45-degree field of view. 2212 by 1659 pixels. Retinal fundus photograph — 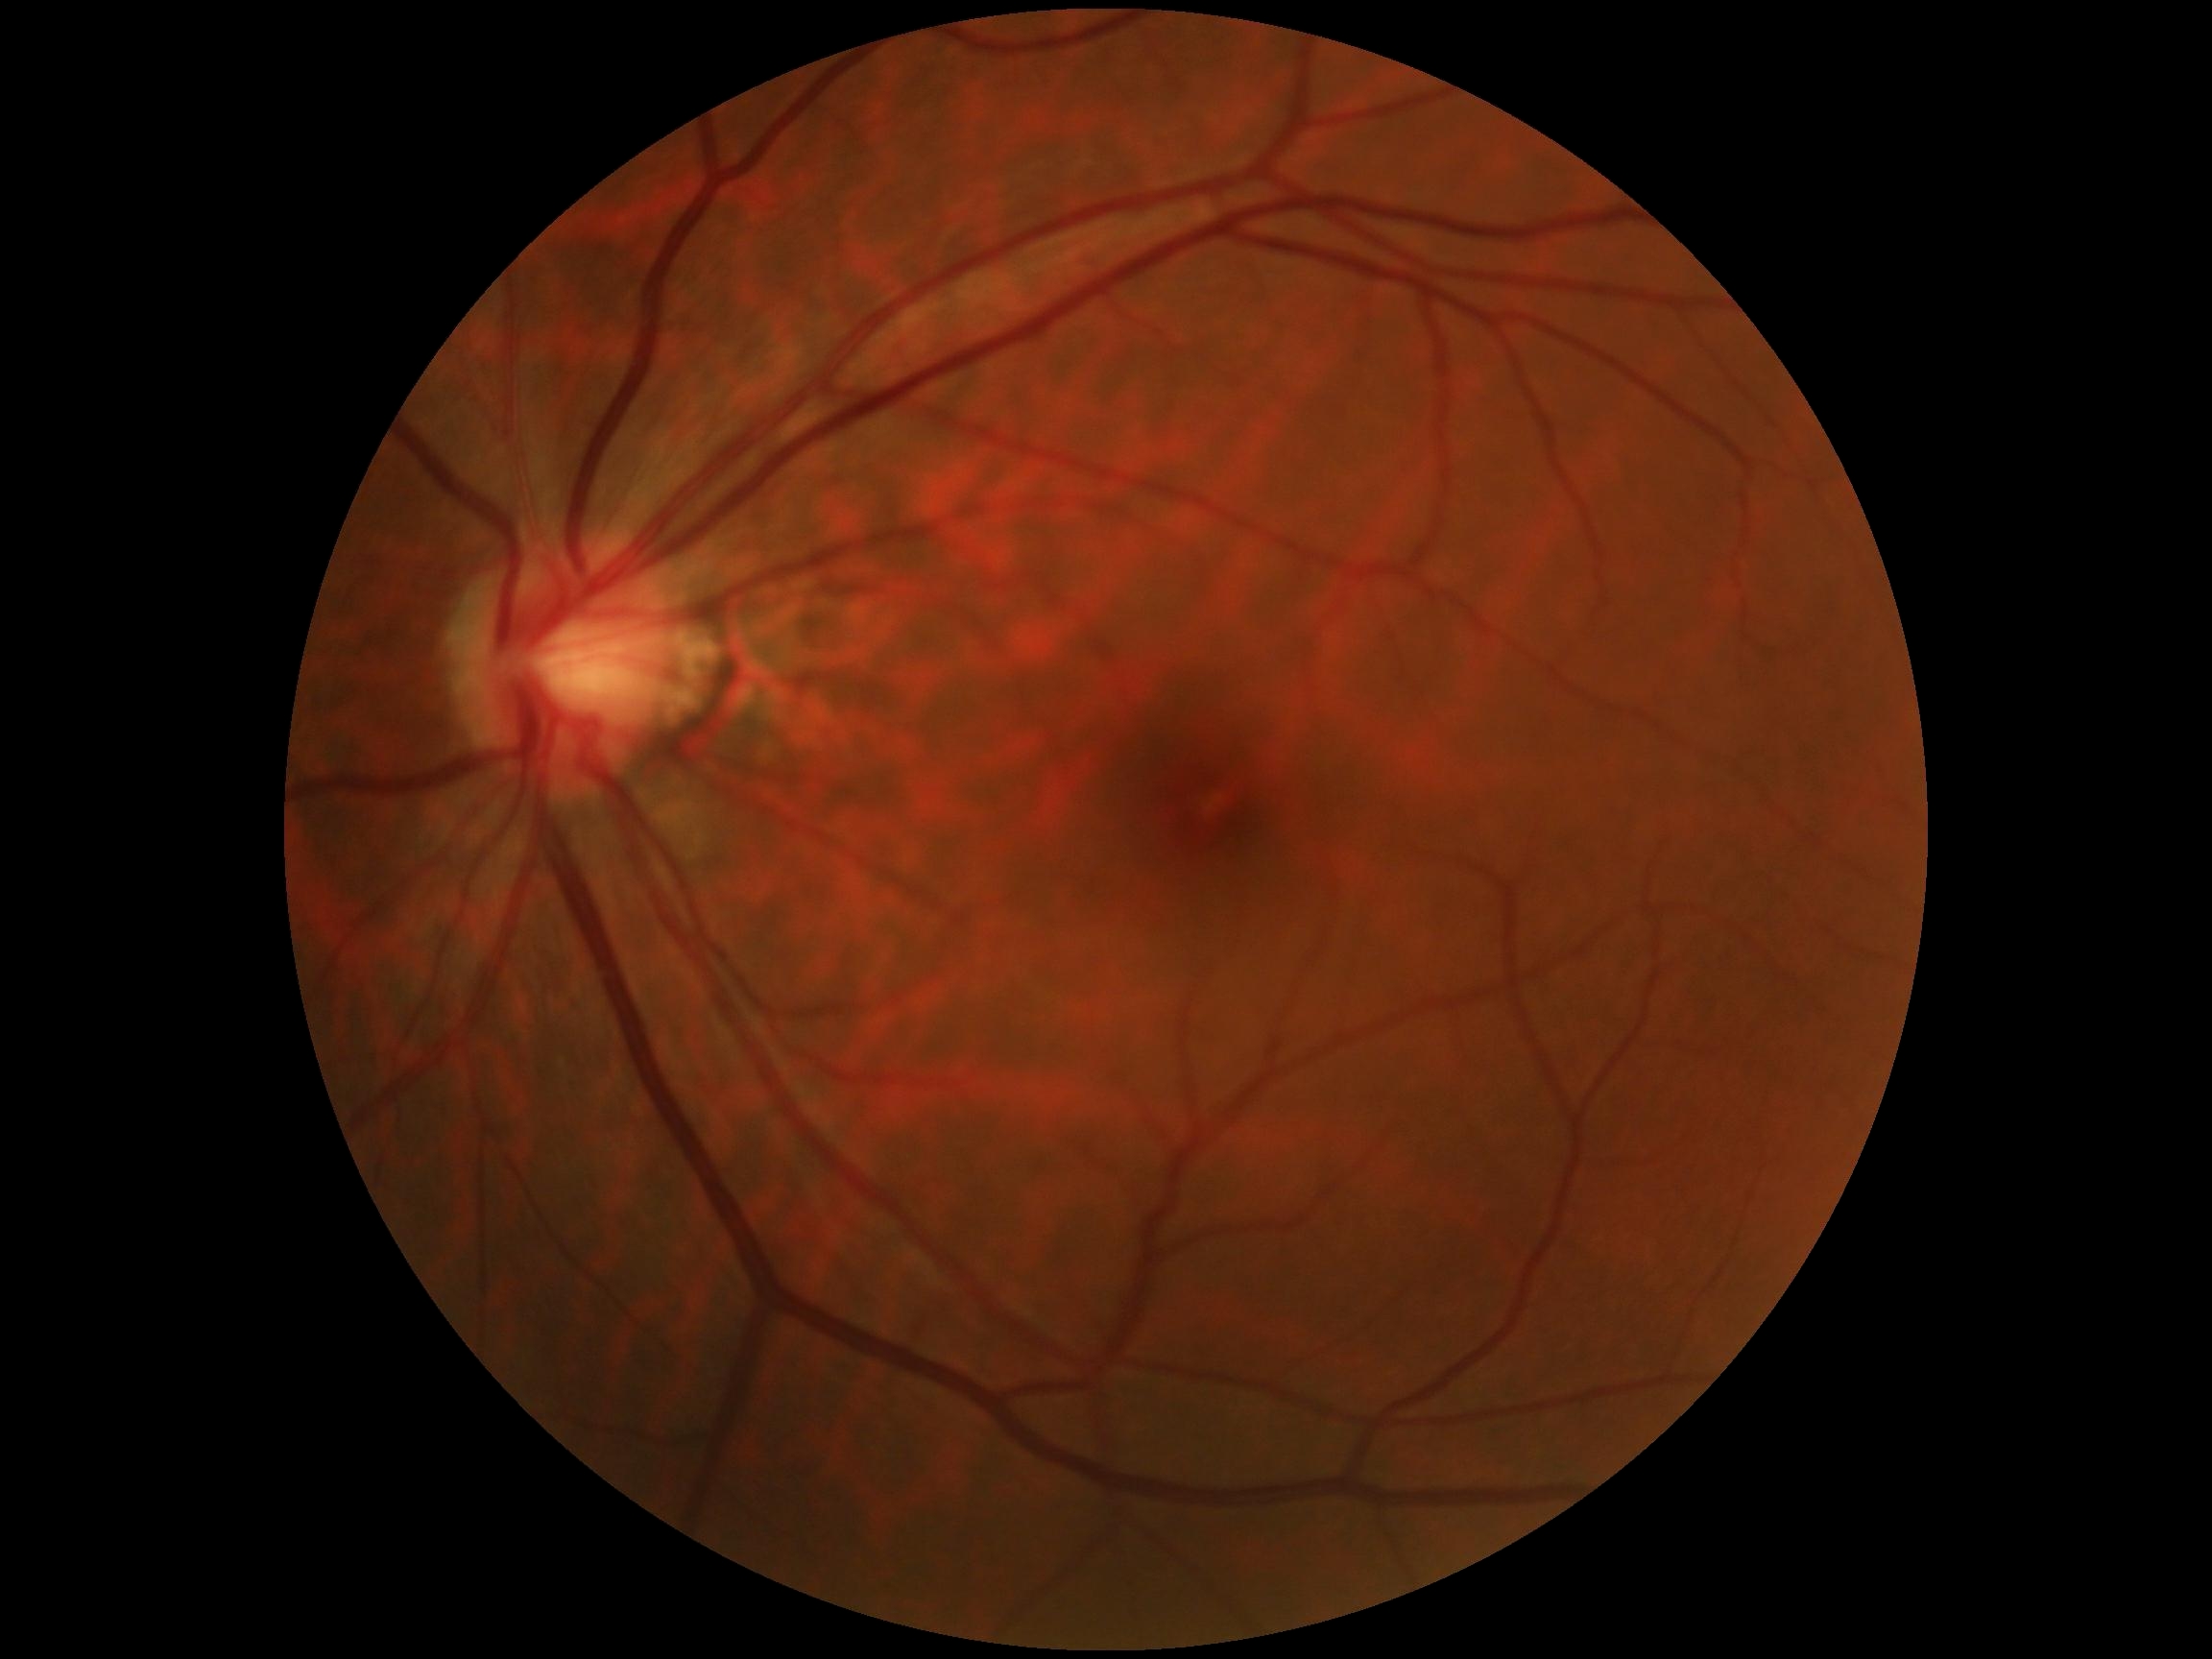

No DR findings.
DR grade: 0.